Wide-field fundus image from infant ROP screening; camera: Phoenix ICON (100° FOV) — 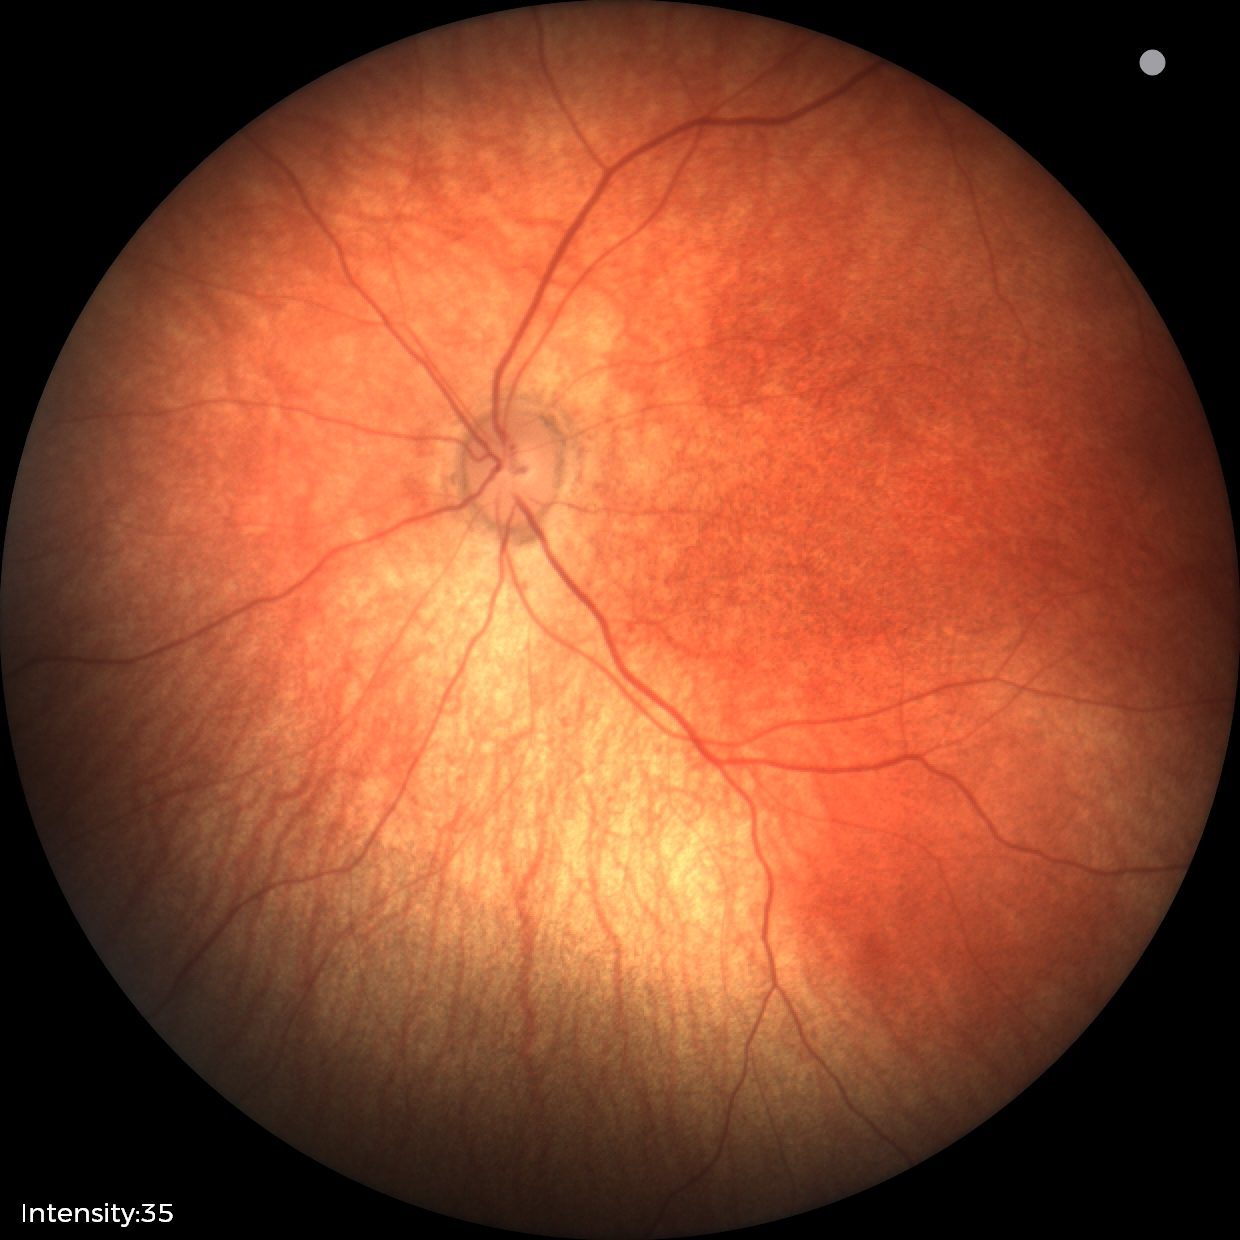

Screening diagnosis: physiological finding.